45° field of view, diabetic retinopathy graded by the modified Davis classification, image size 848x848.
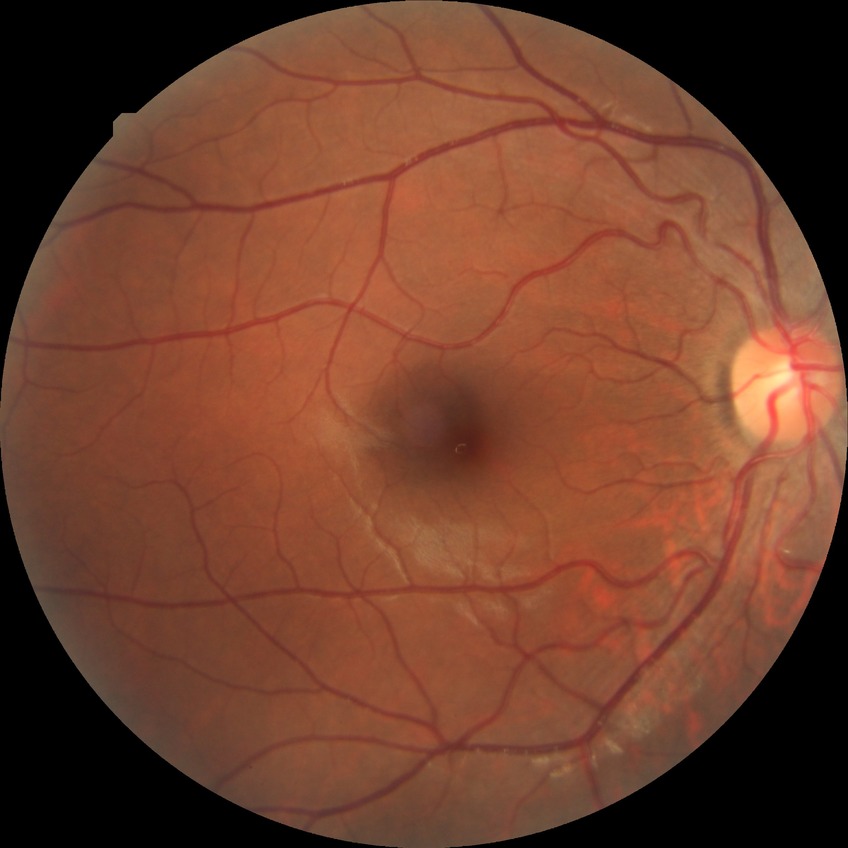 Diabetic retinopathy (DR): NDR (no diabetic retinopathy).